Graded on the modified Davis scale: 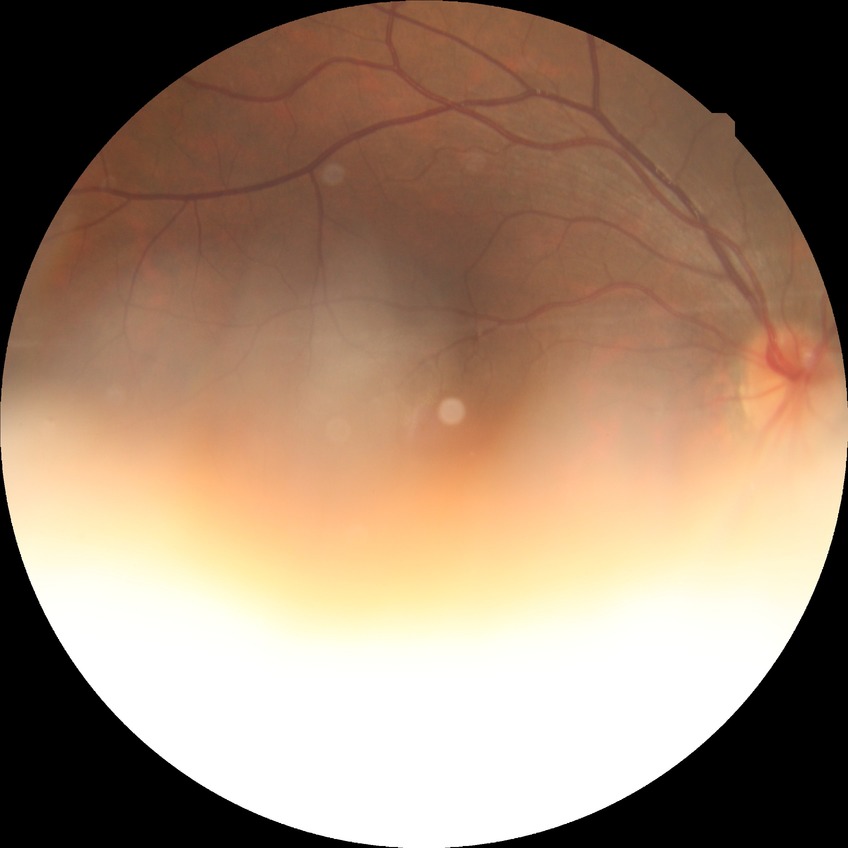

Diabetic retinopathy (DR): NDR (no diabetic retinopathy).